Color fundus photograph. 45-degree field of view.
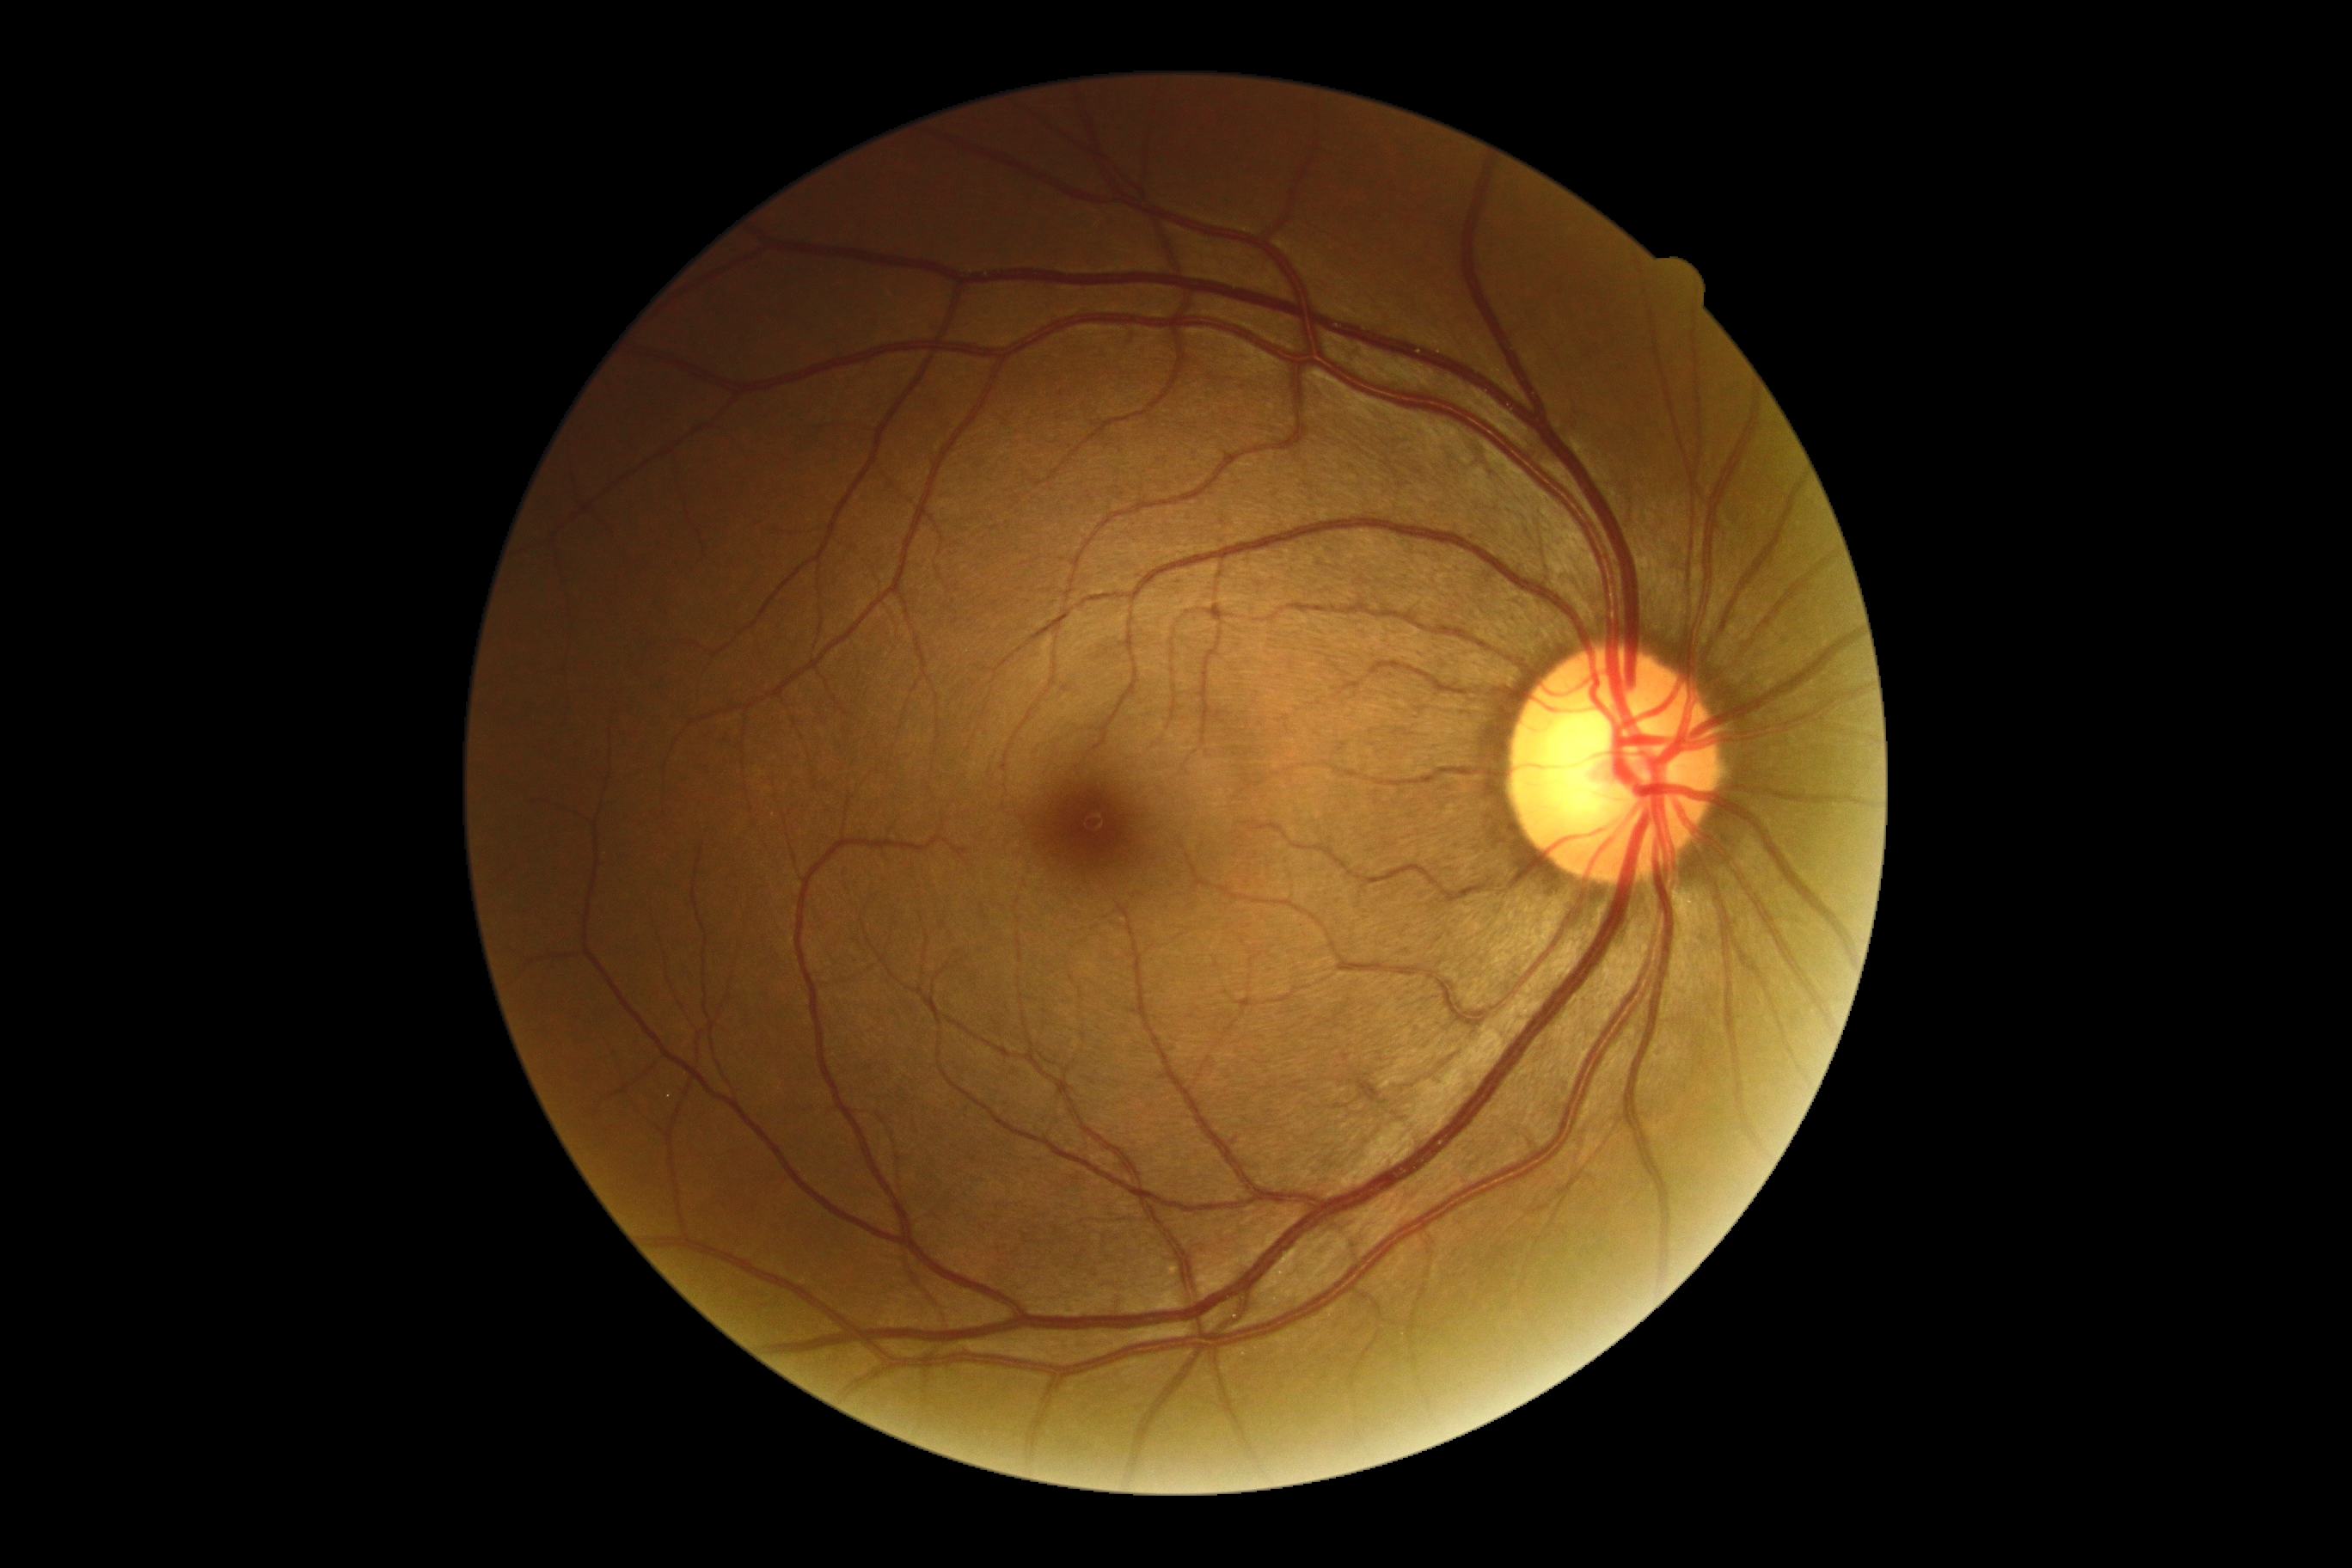

DR is no apparent diabetic retinopathy (grade 0).